Acquired on the Phoenix ICON; wide-field fundus photograph from neonatal ROP screening; 1240 by 1240 pixels
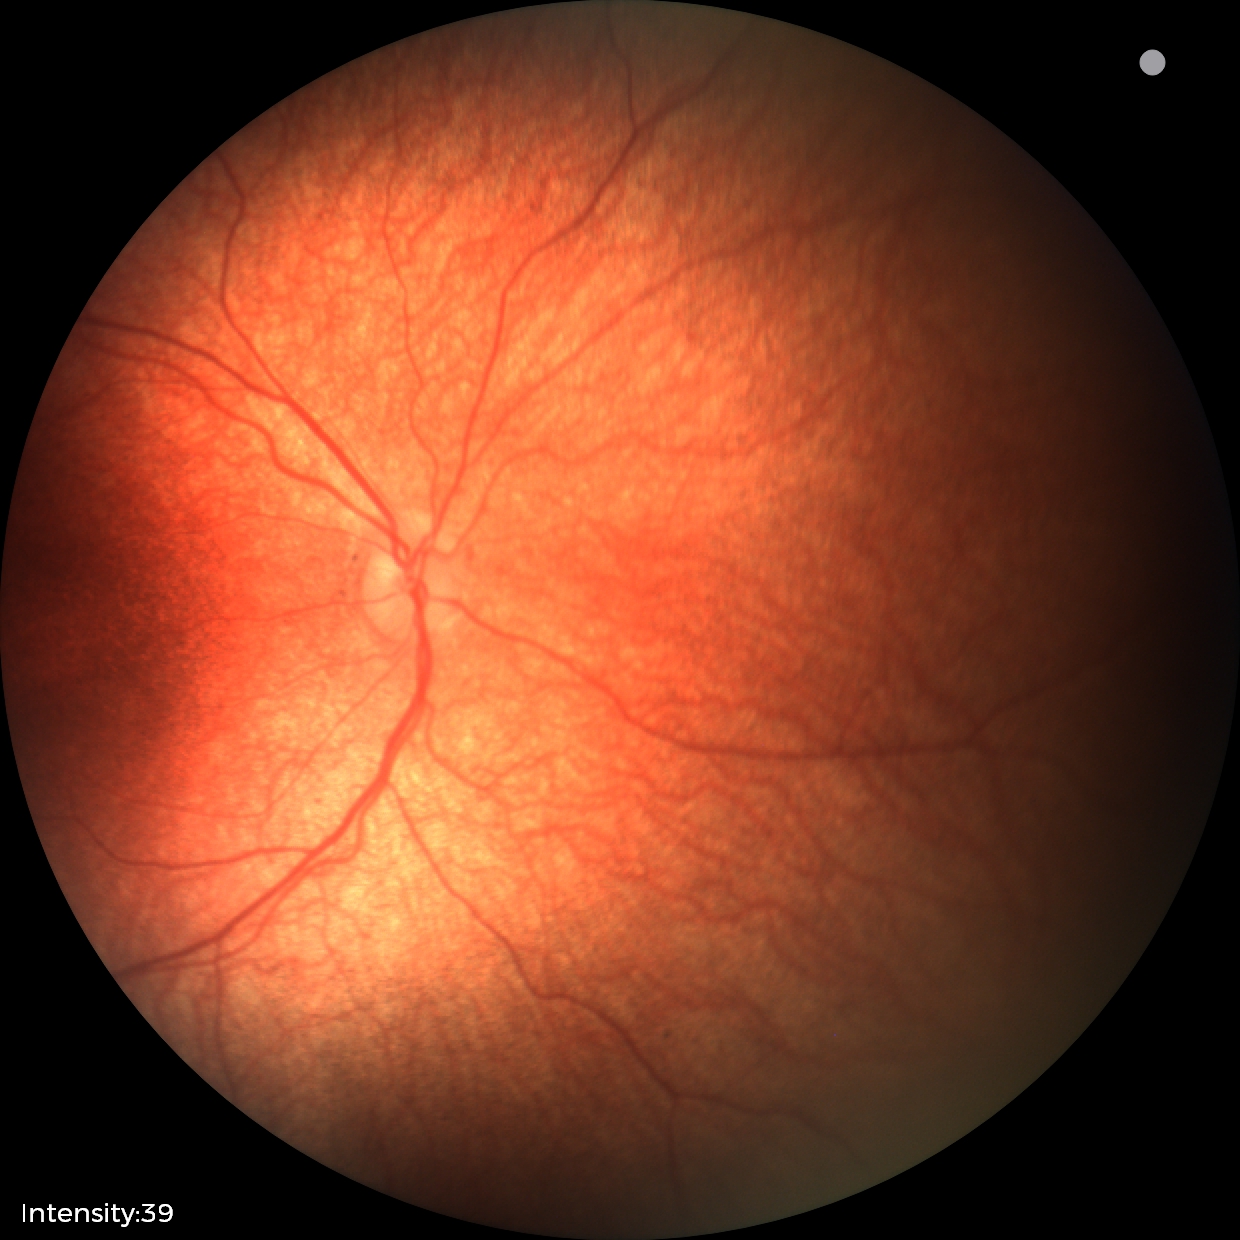

Examination with physiological retinal findings.